Pediatric retinal photograph (wide-field); image size 640x480 — 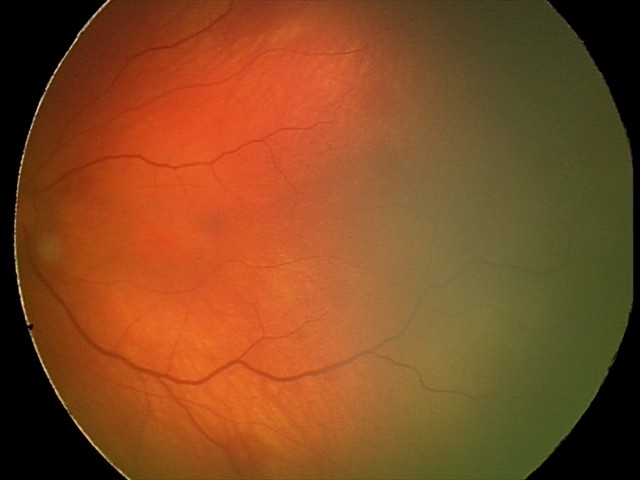

Screening examination consistent with retinal hemorrhages.